Modified Davis classification:
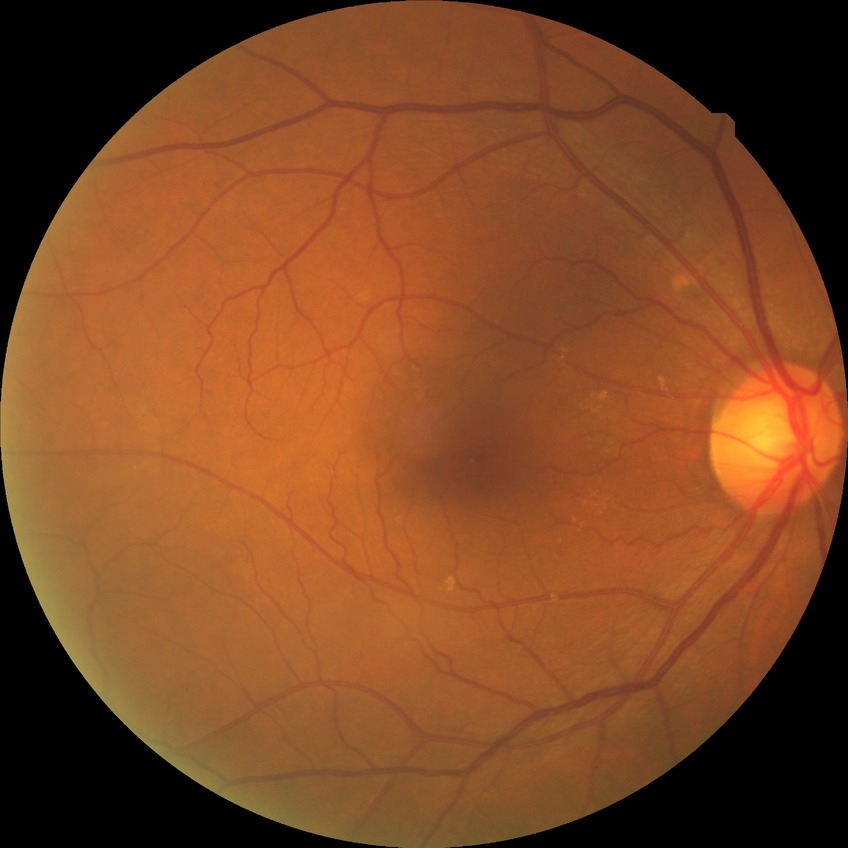

retinopathy stage: simple diabetic retinopathy.